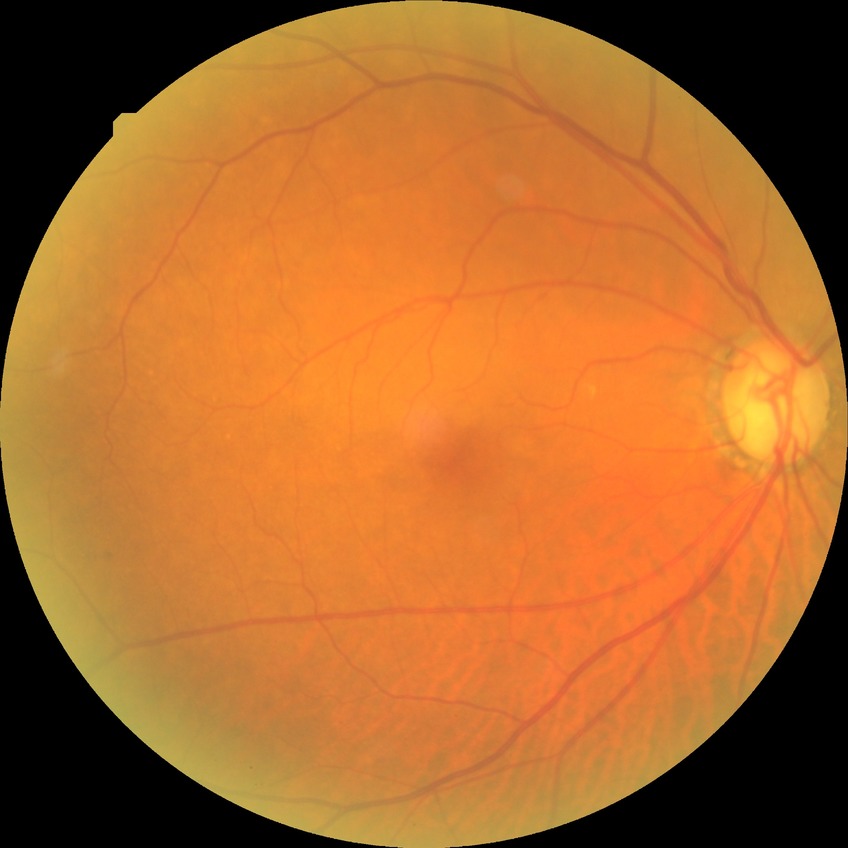 diabetic retinopathy (DR) = NDR (no diabetic retinopathy).